Posterior pole color fundus photograph. 45° FOV: 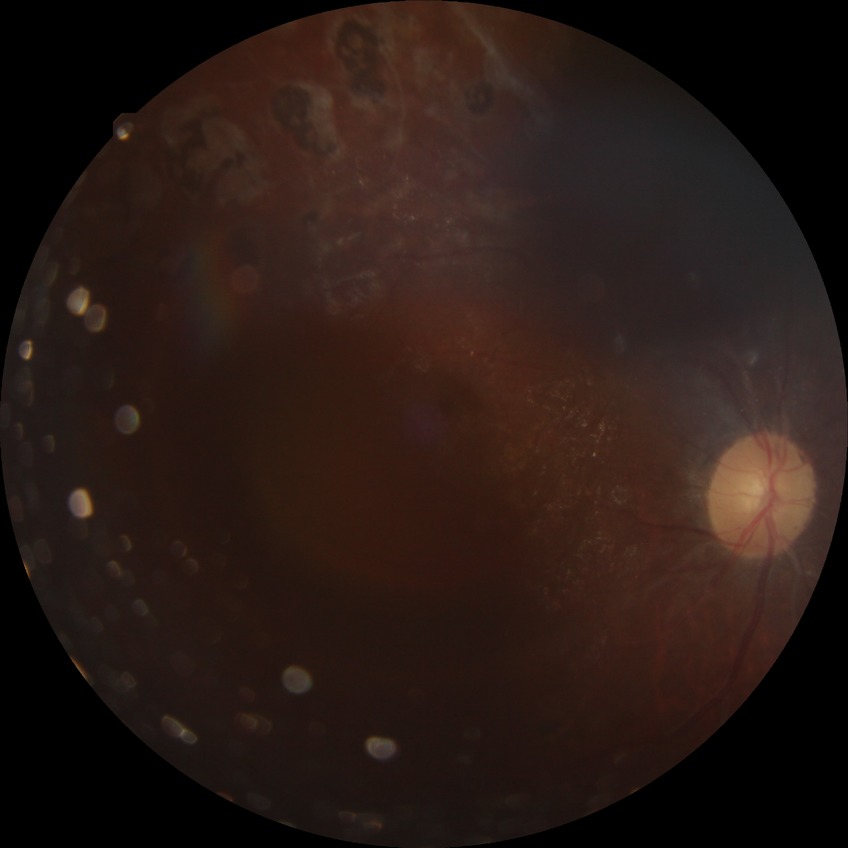
Modified Davis grading: proliferative diabetic retinopathy.